1659x2212
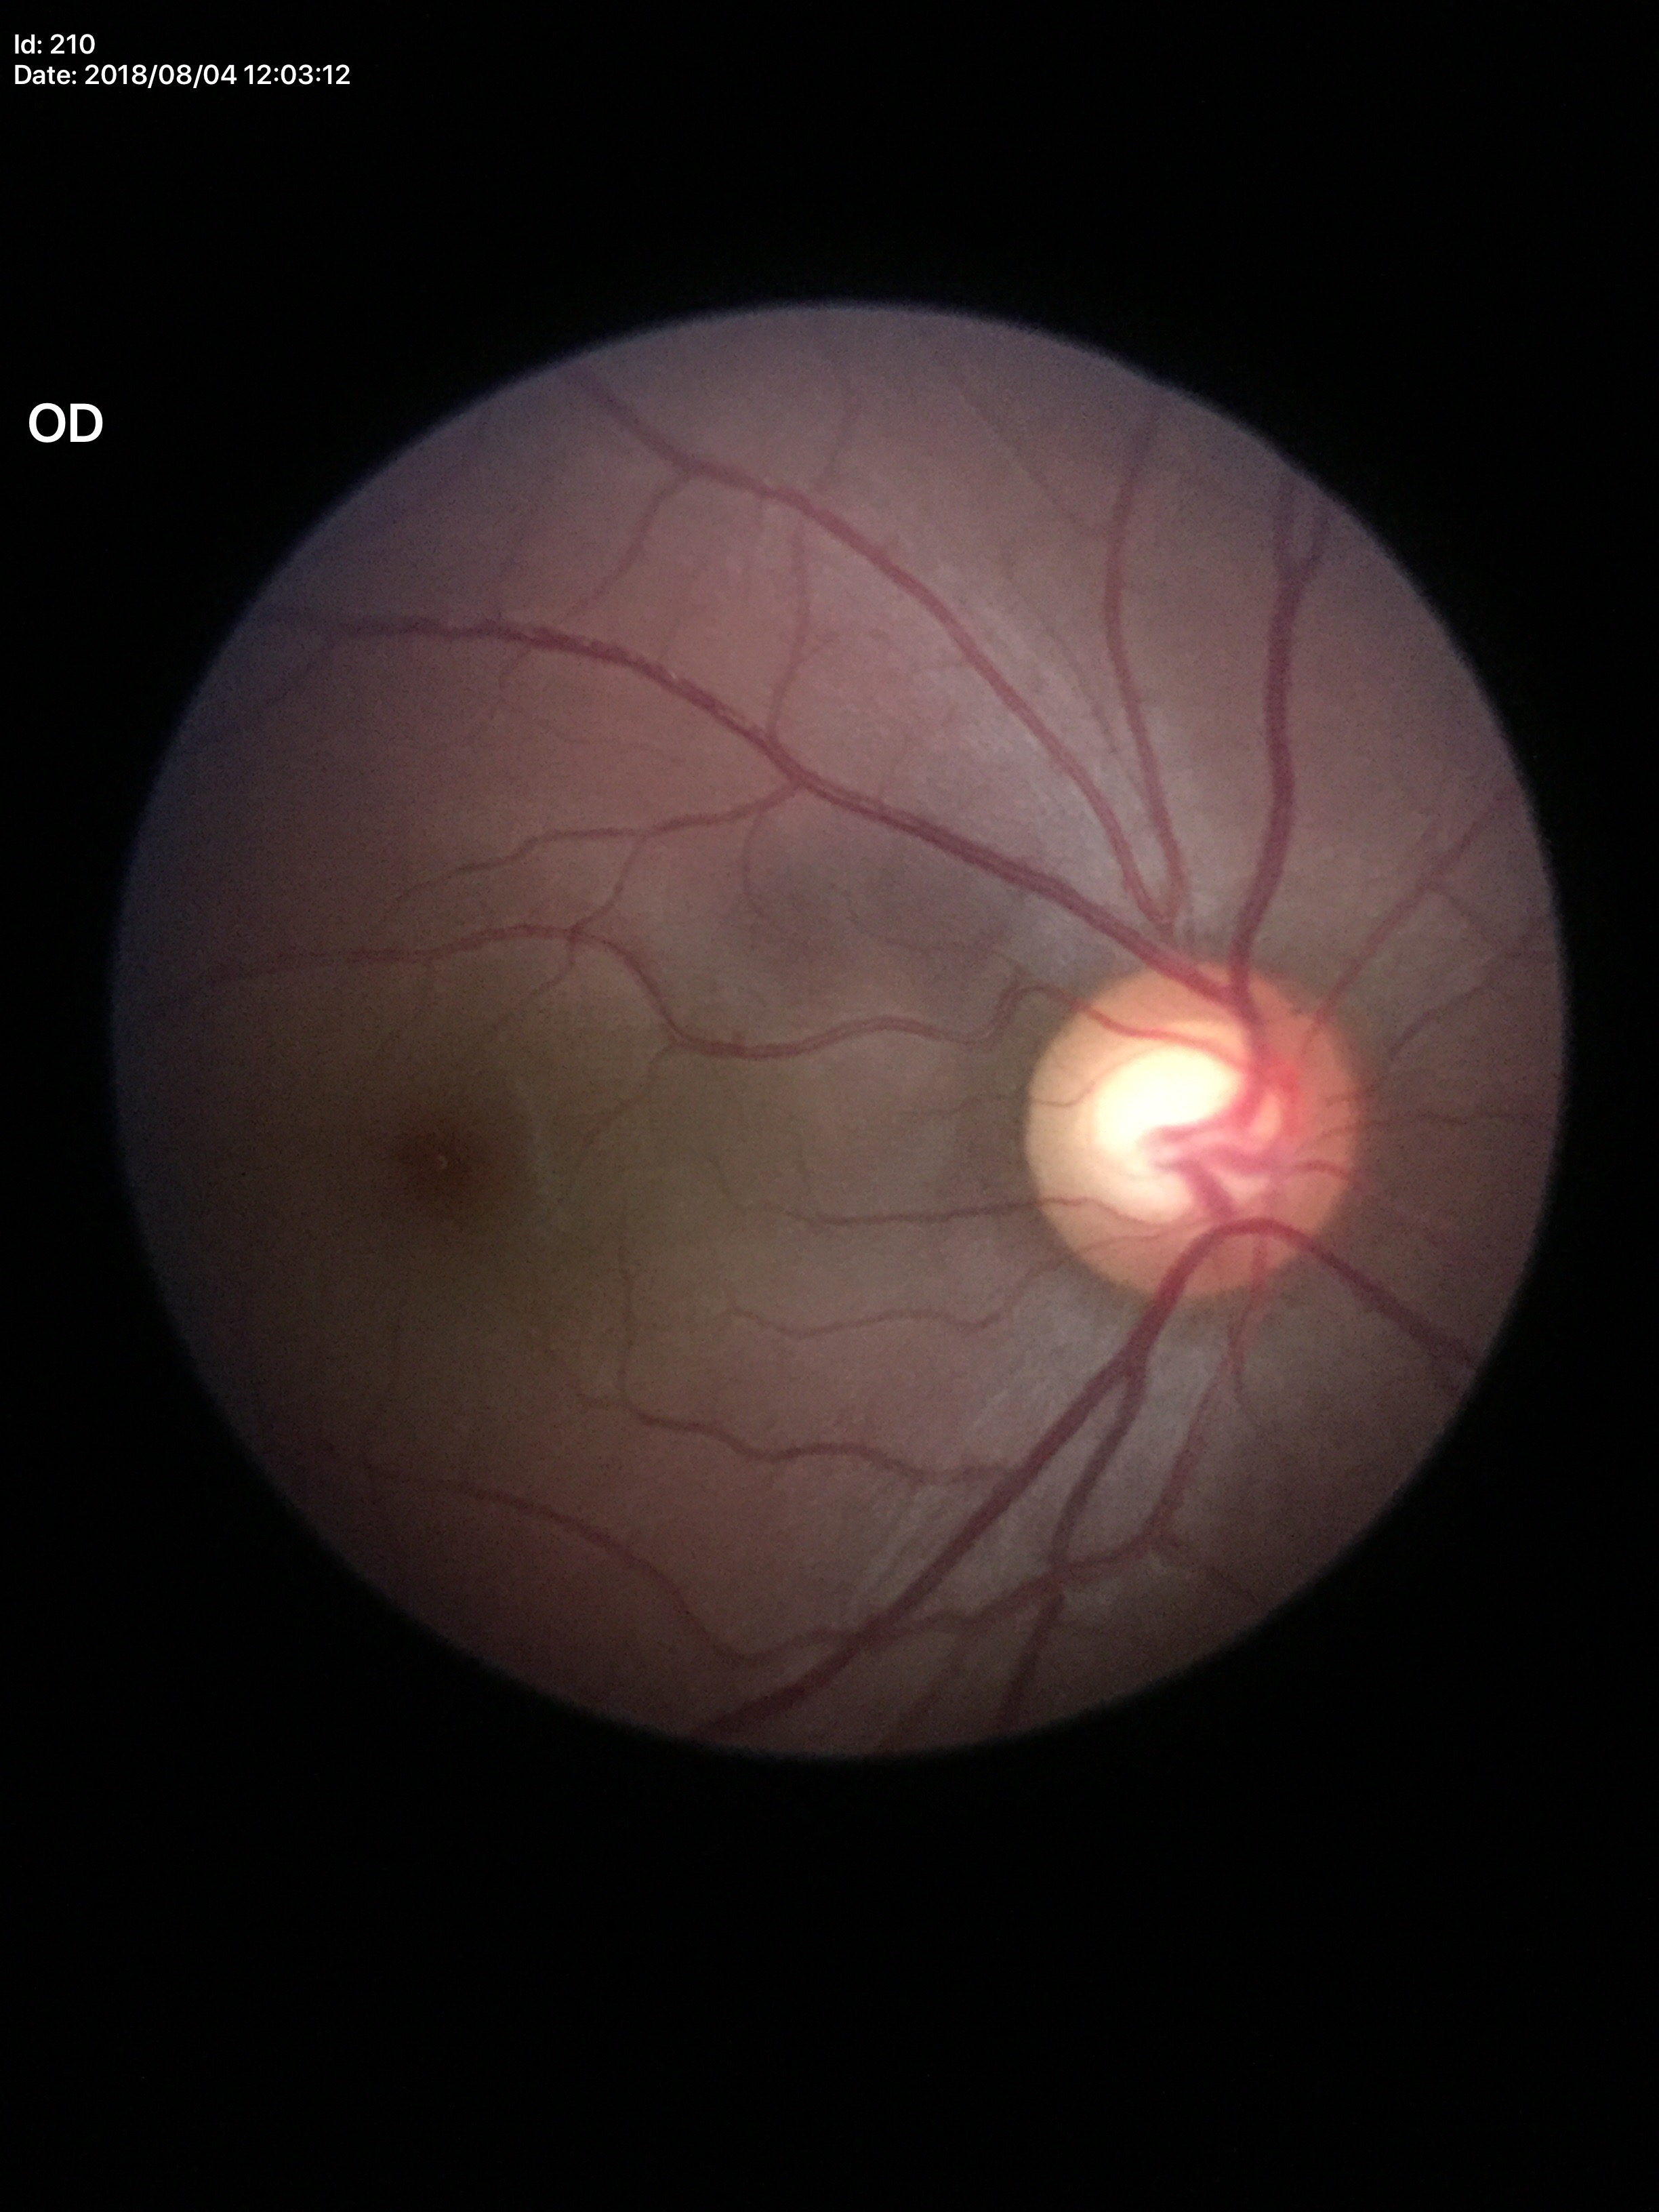

Glaucoma-suspect optic disc appearance. Vertical C/D ratio of 0.65.